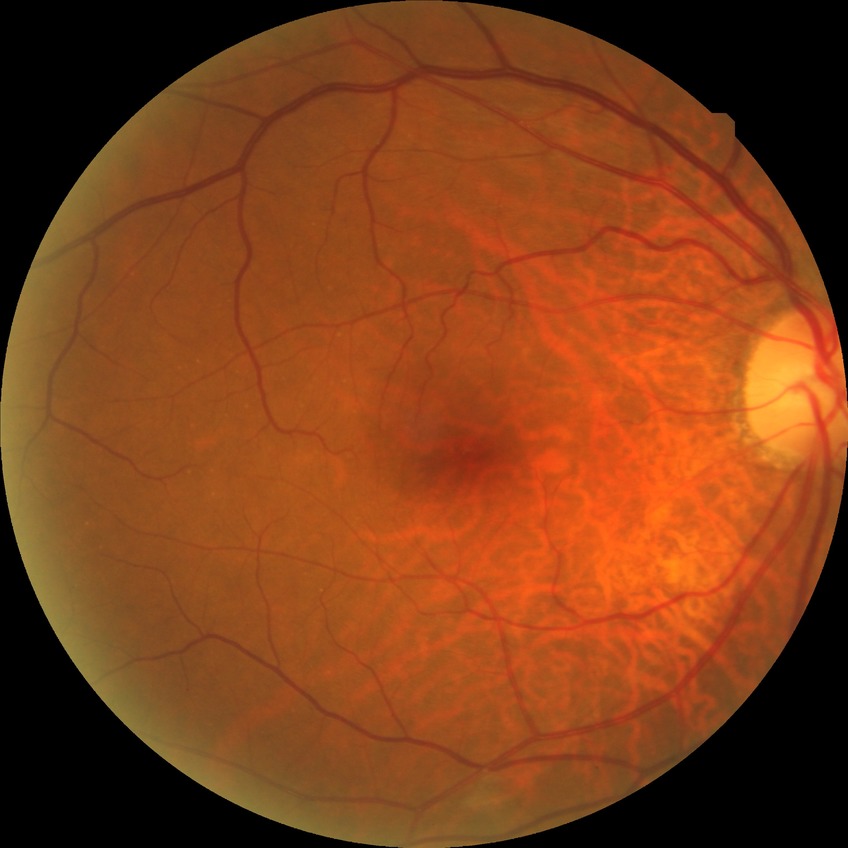 {"davis_grade": "SDR", "proliferative_class": "non-proliferative diabetic retinopathy"}